848 by 848 pixels; 45° FOV; modified Davis classification; acquired with a NIDEK AFC-230.
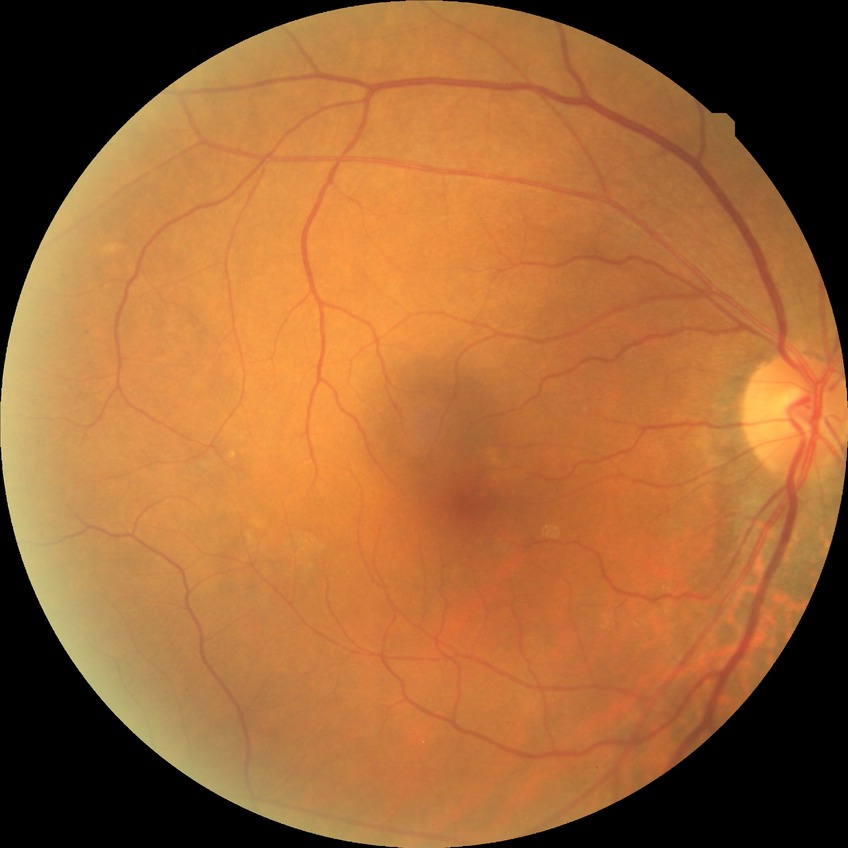 davis_grade: NDR (no diabetic retinopathy)